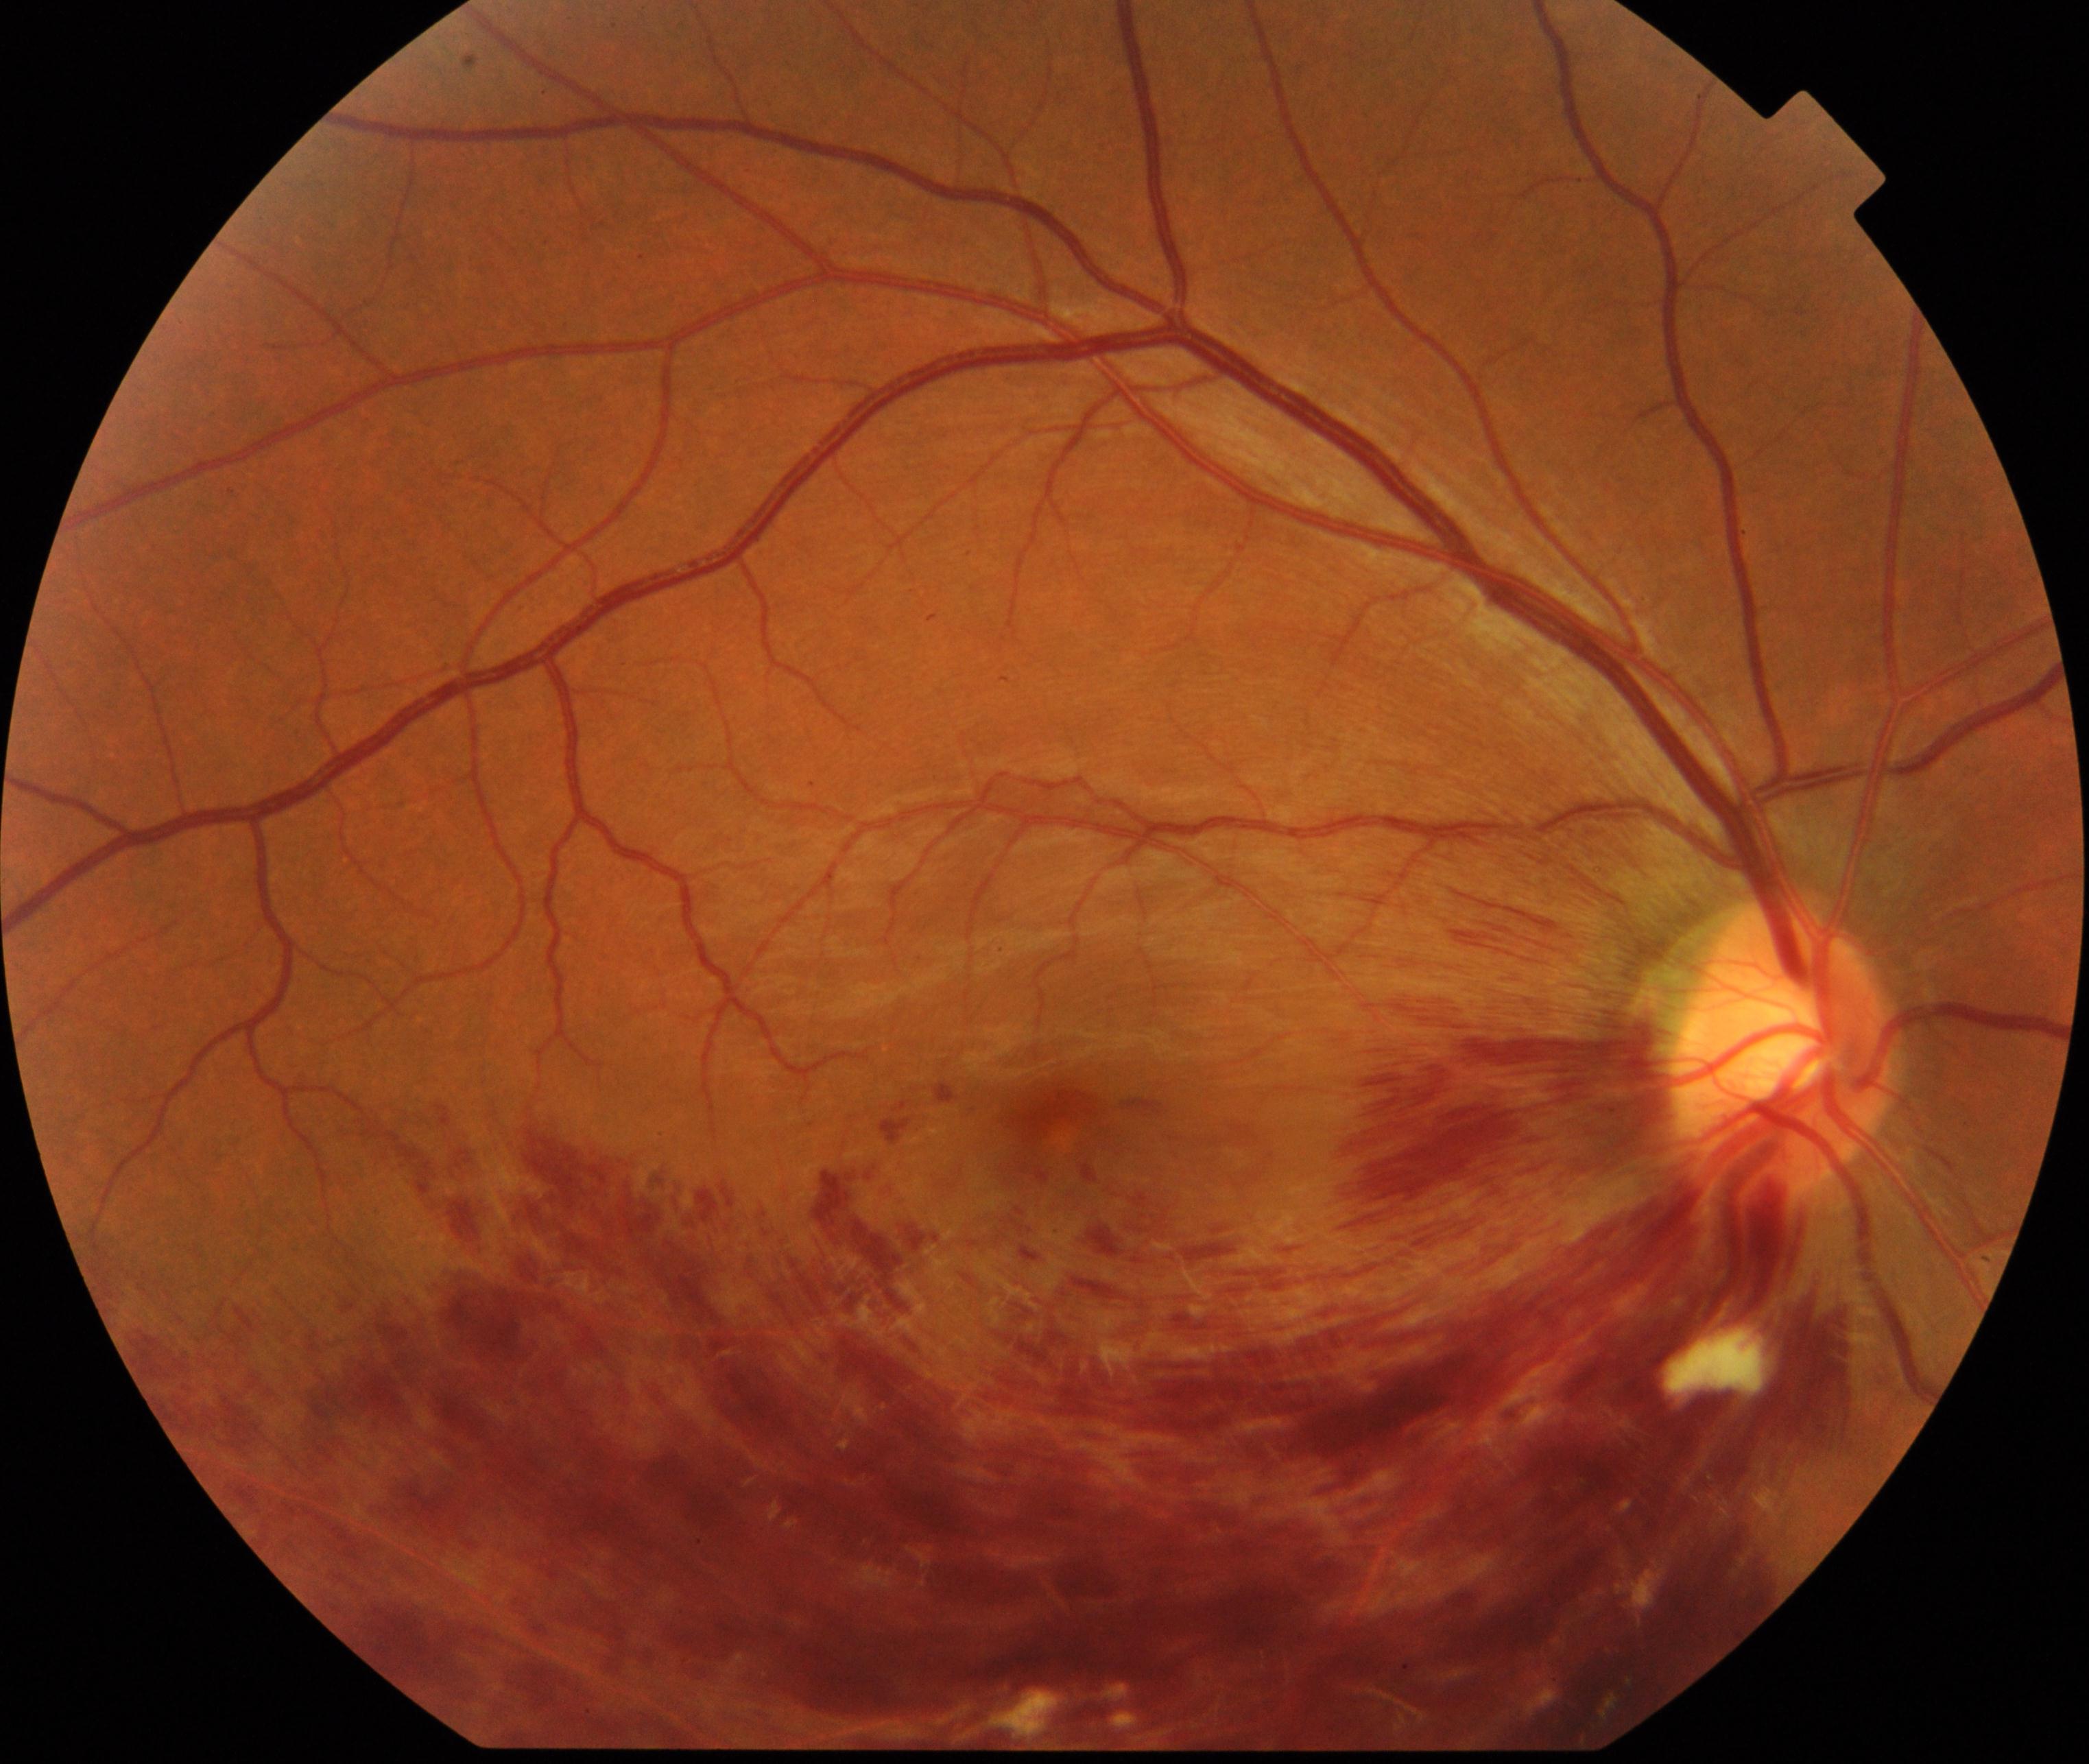
This fundus photograph shows branch retinal vein occlusion (BRVO).